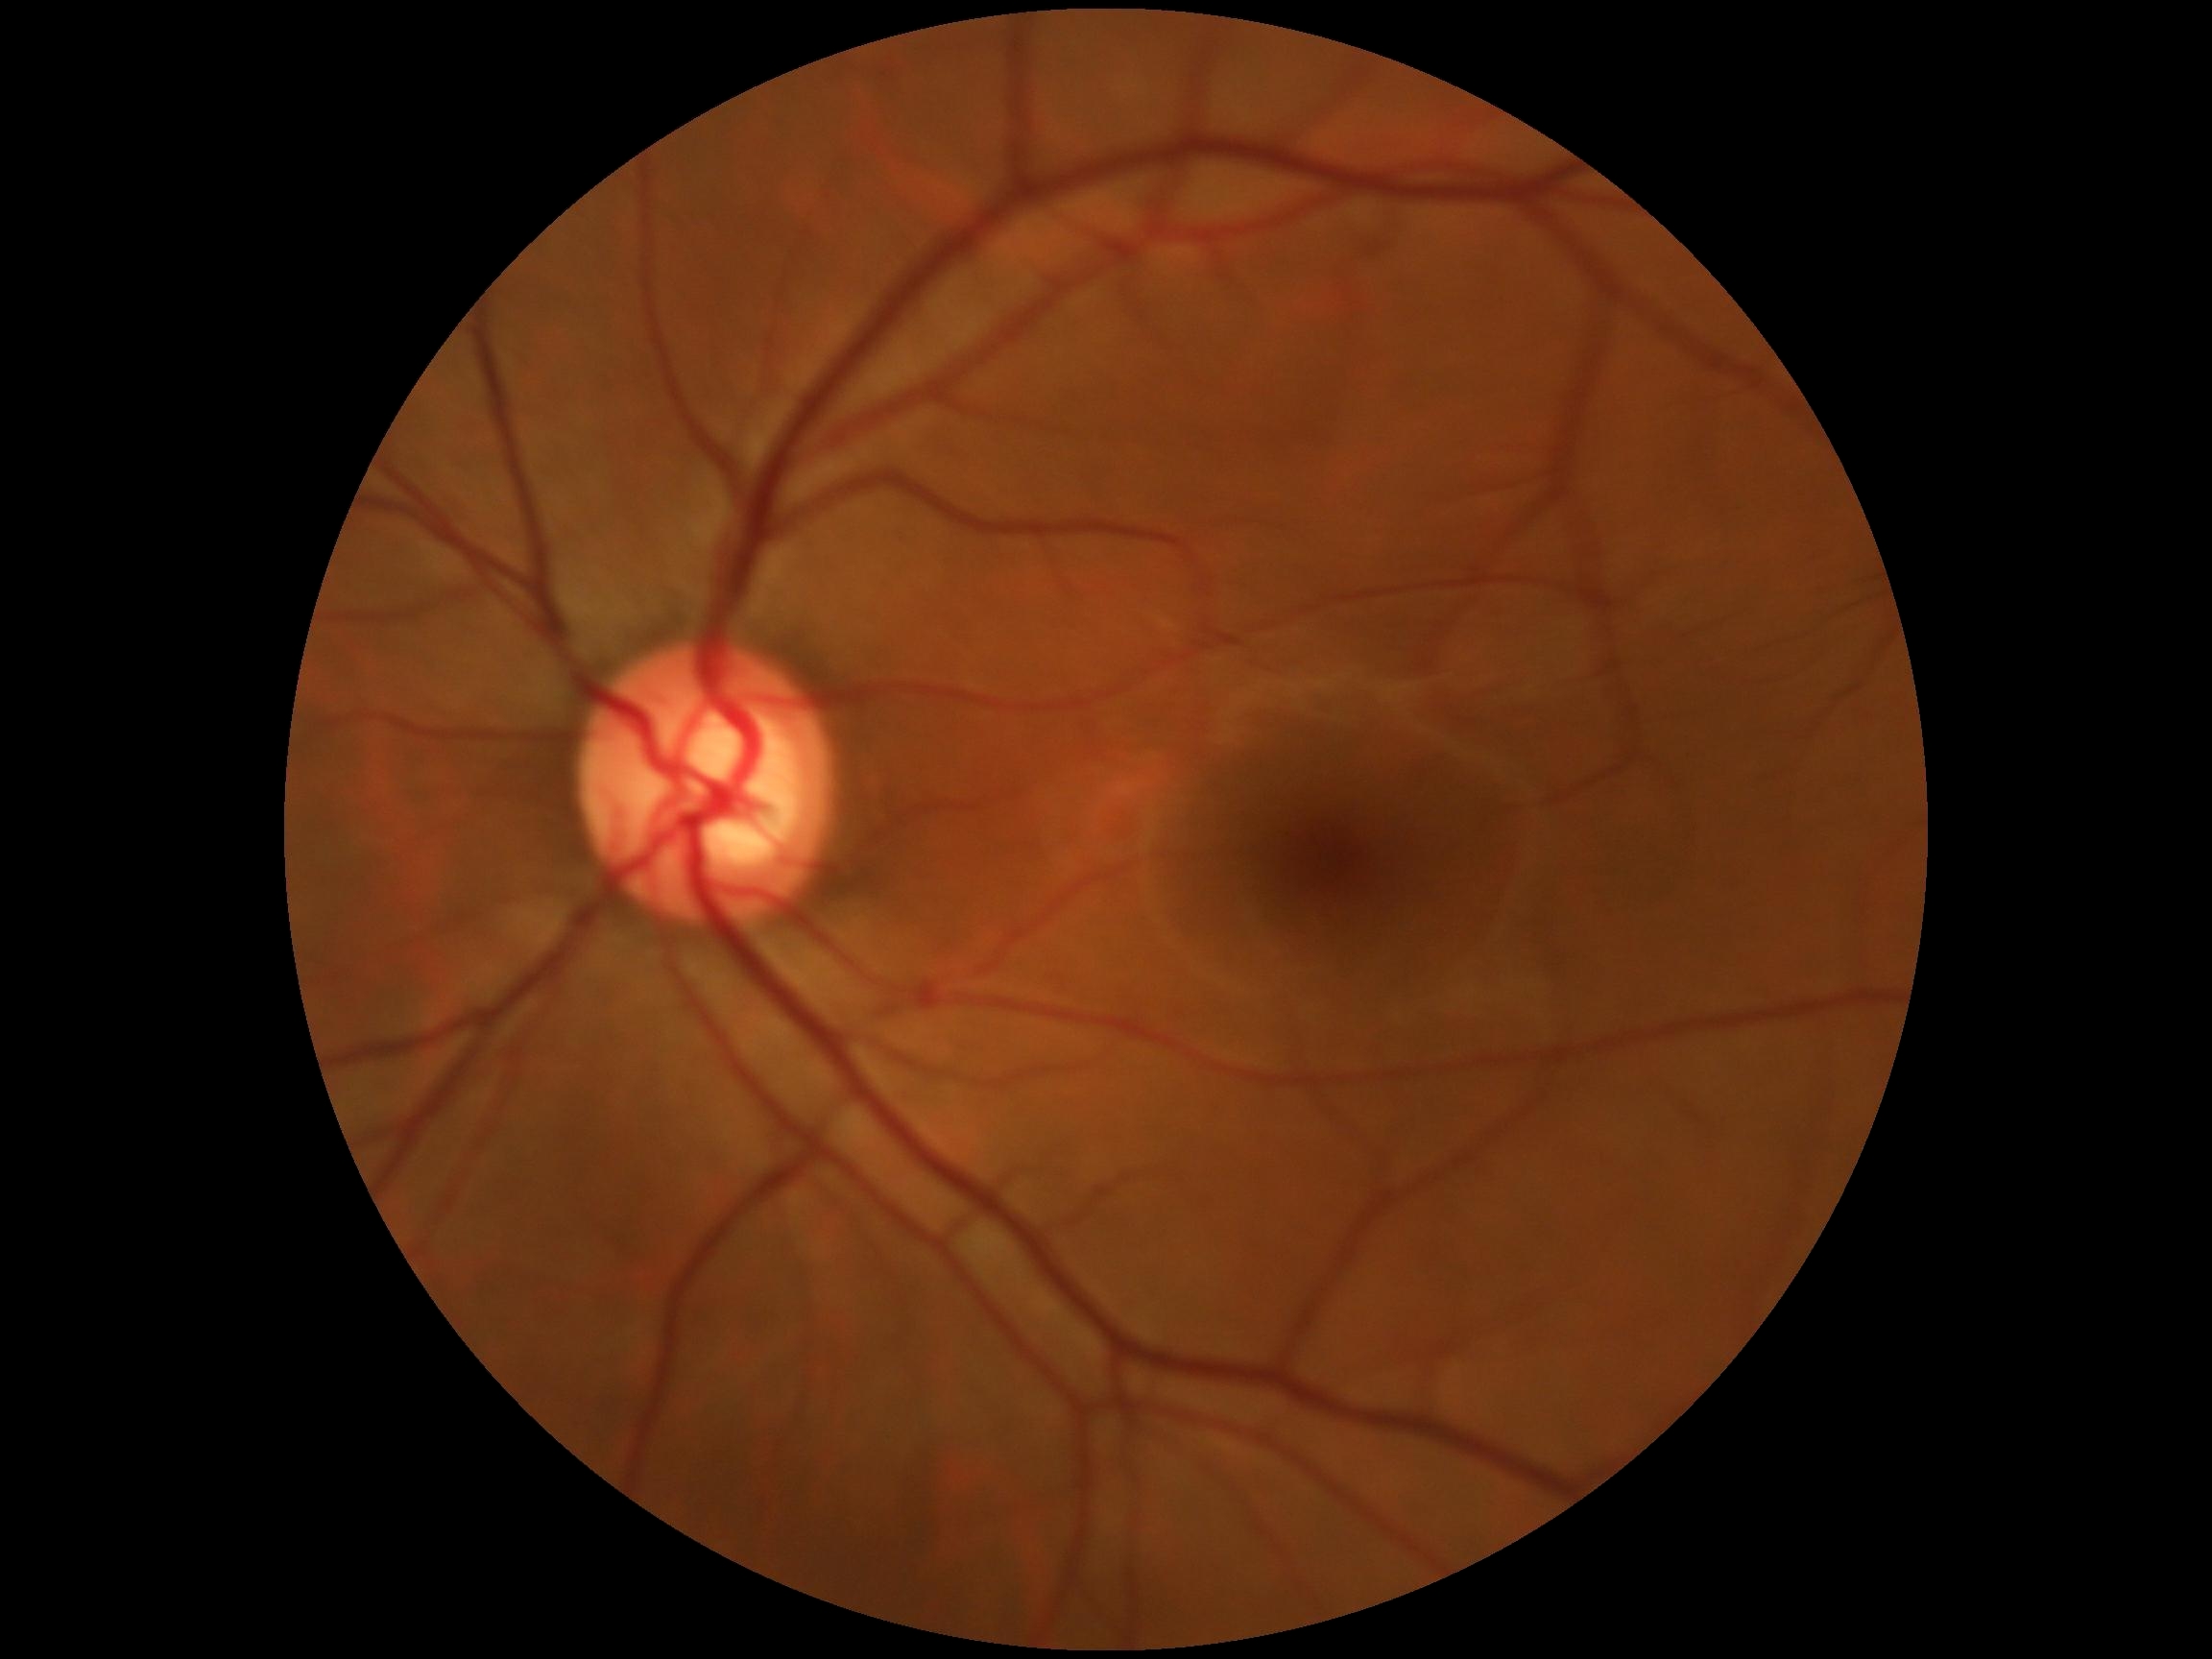 Retinopathy: grade 0 (no apparent retinopathy).